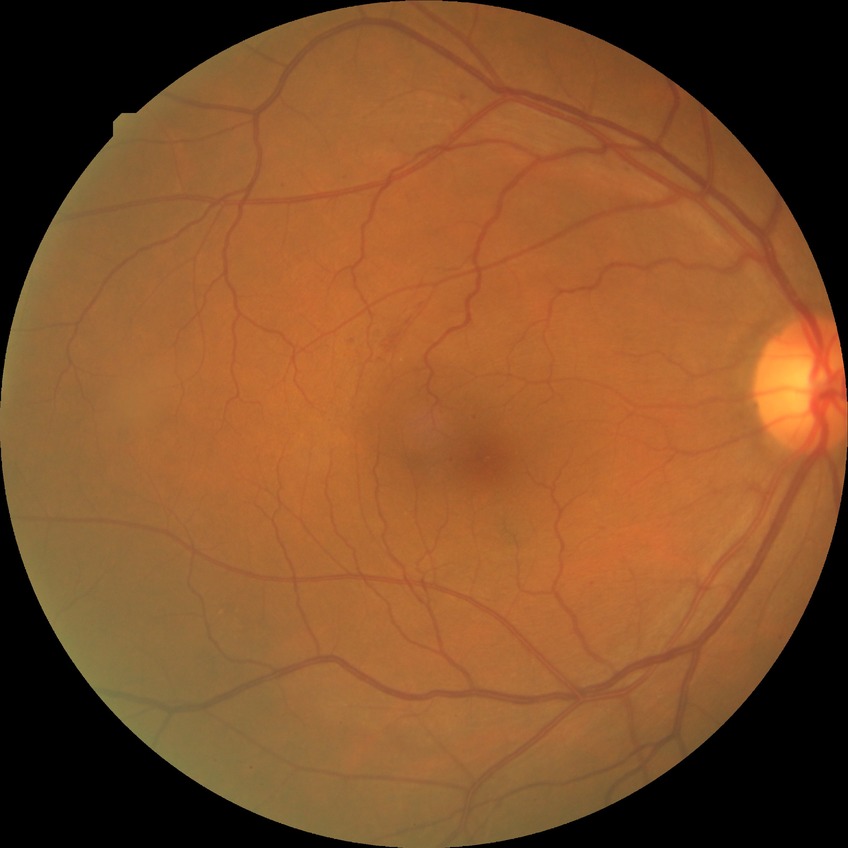 Disease class: non-proliferative diabetic retinopathy. Modified Davis grade: SDR.